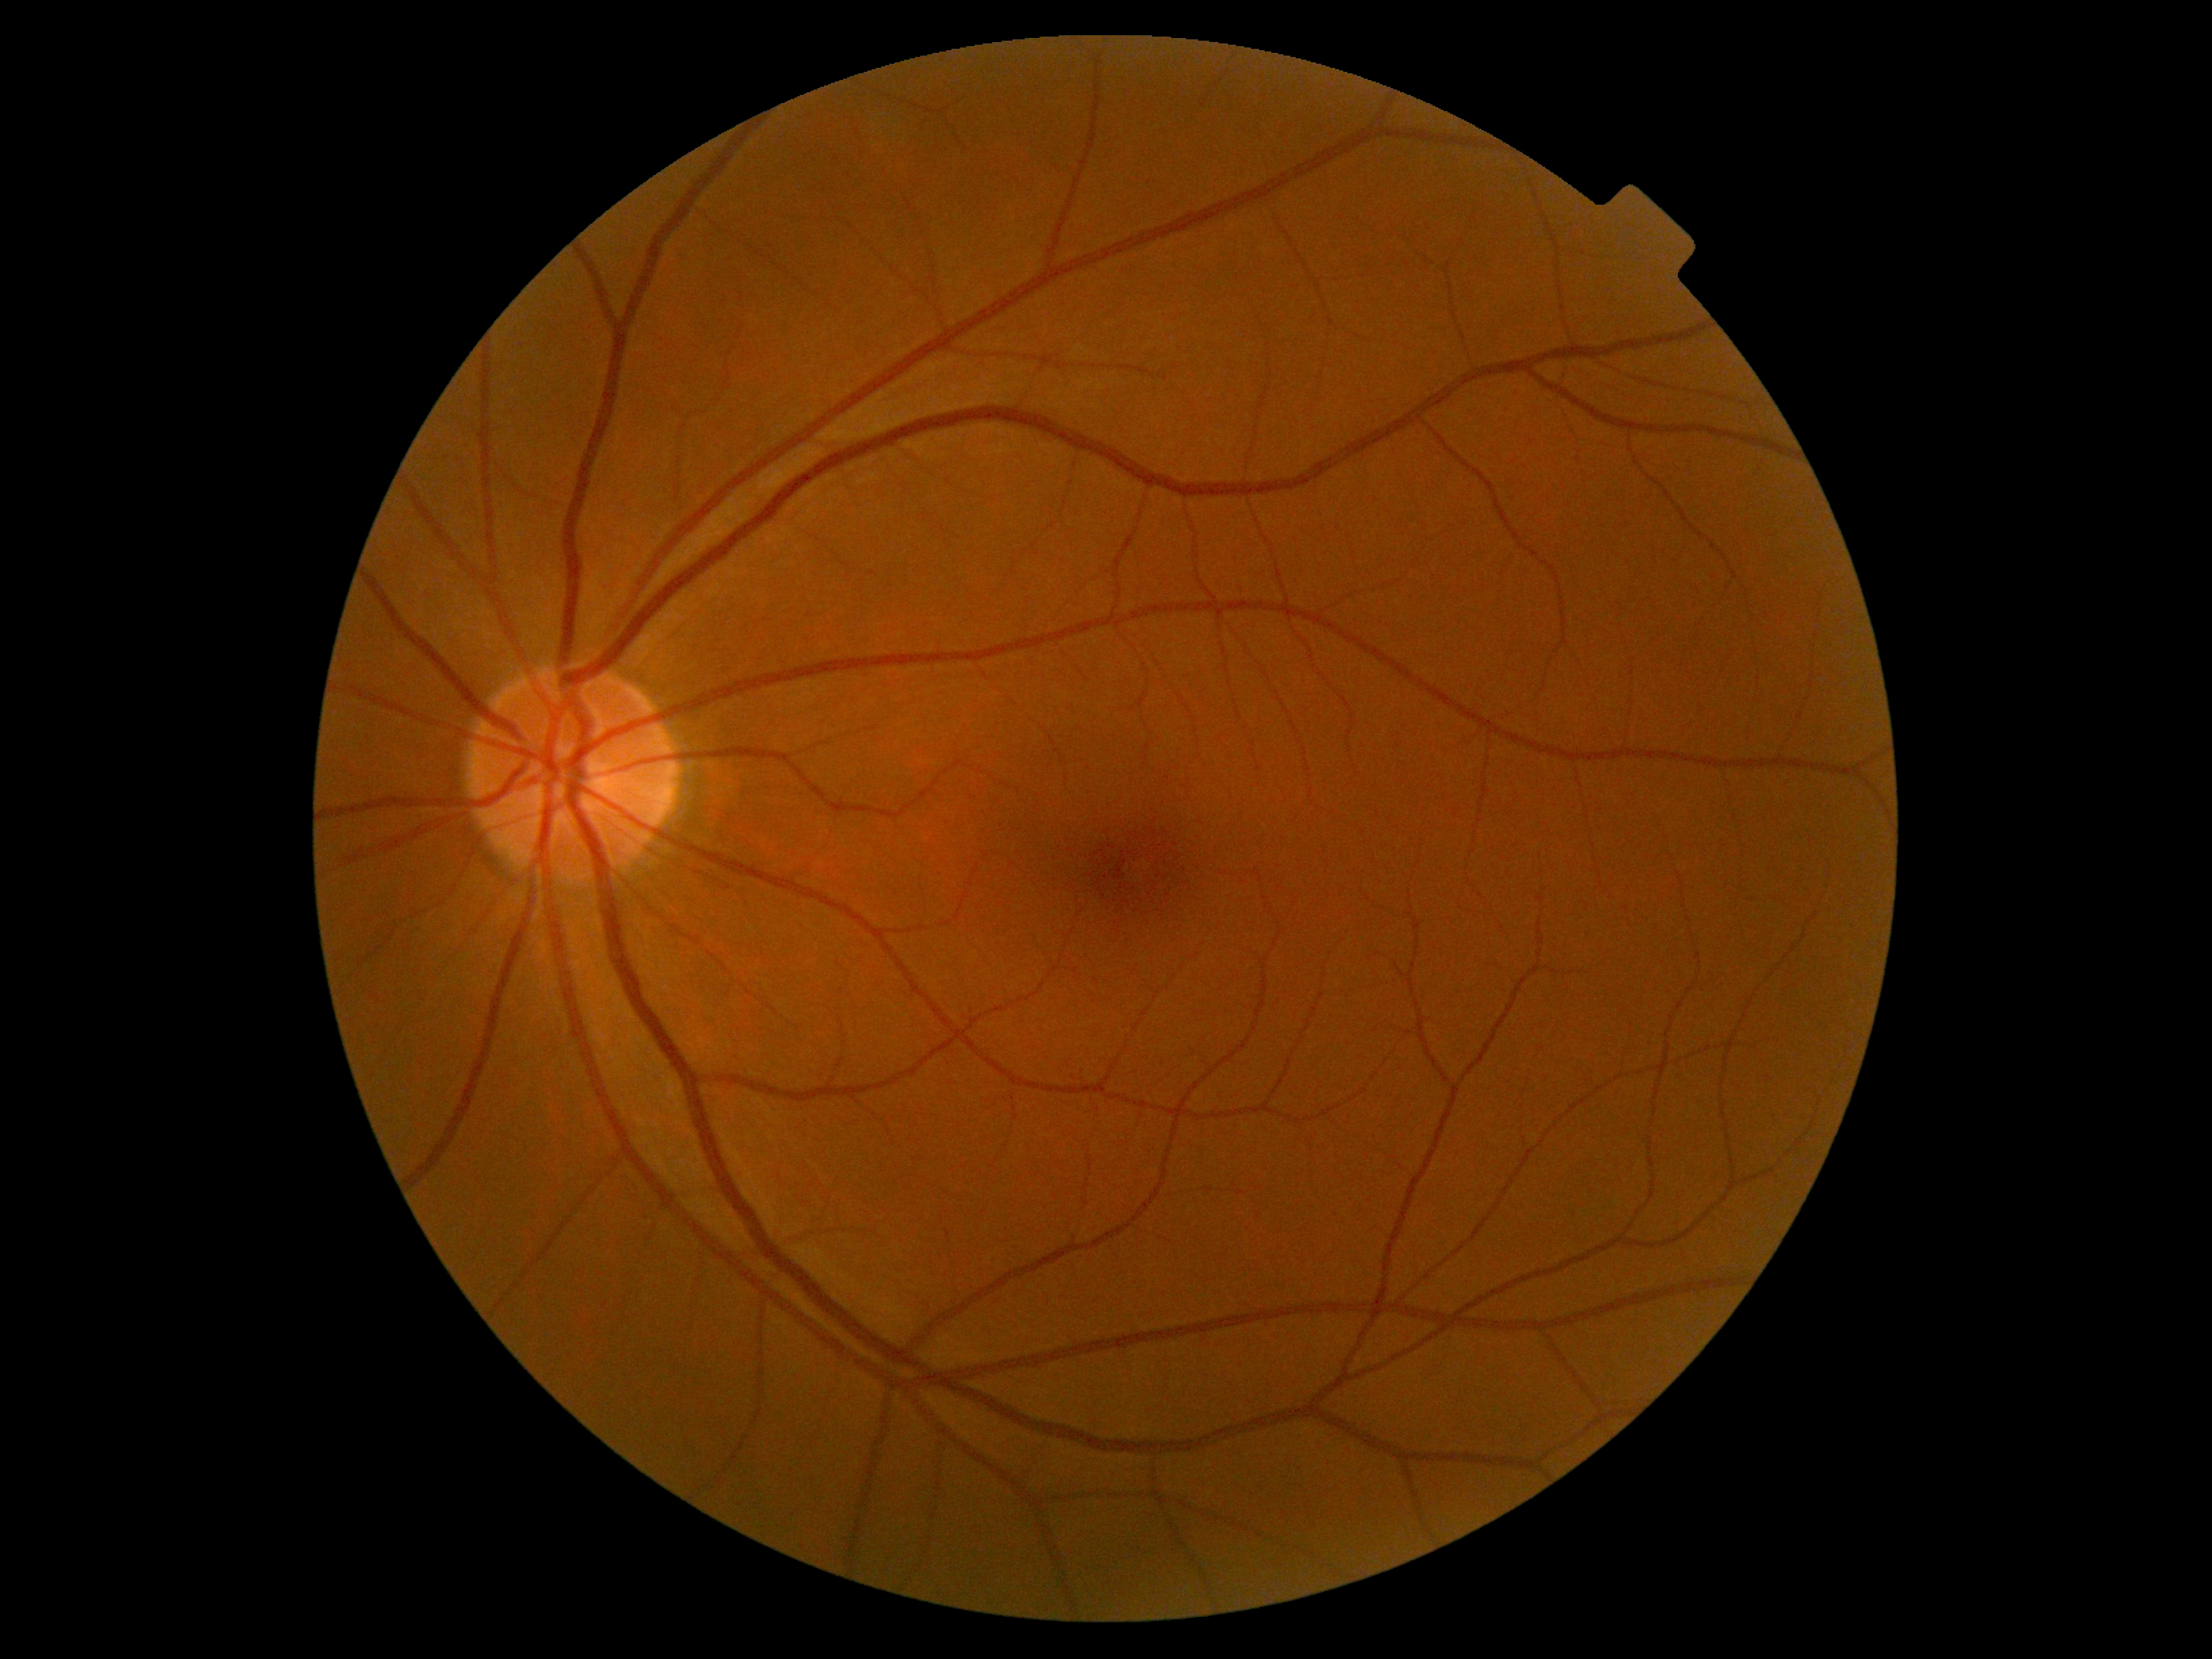

Annotations:
• DR grade — 0